2352x1568px: 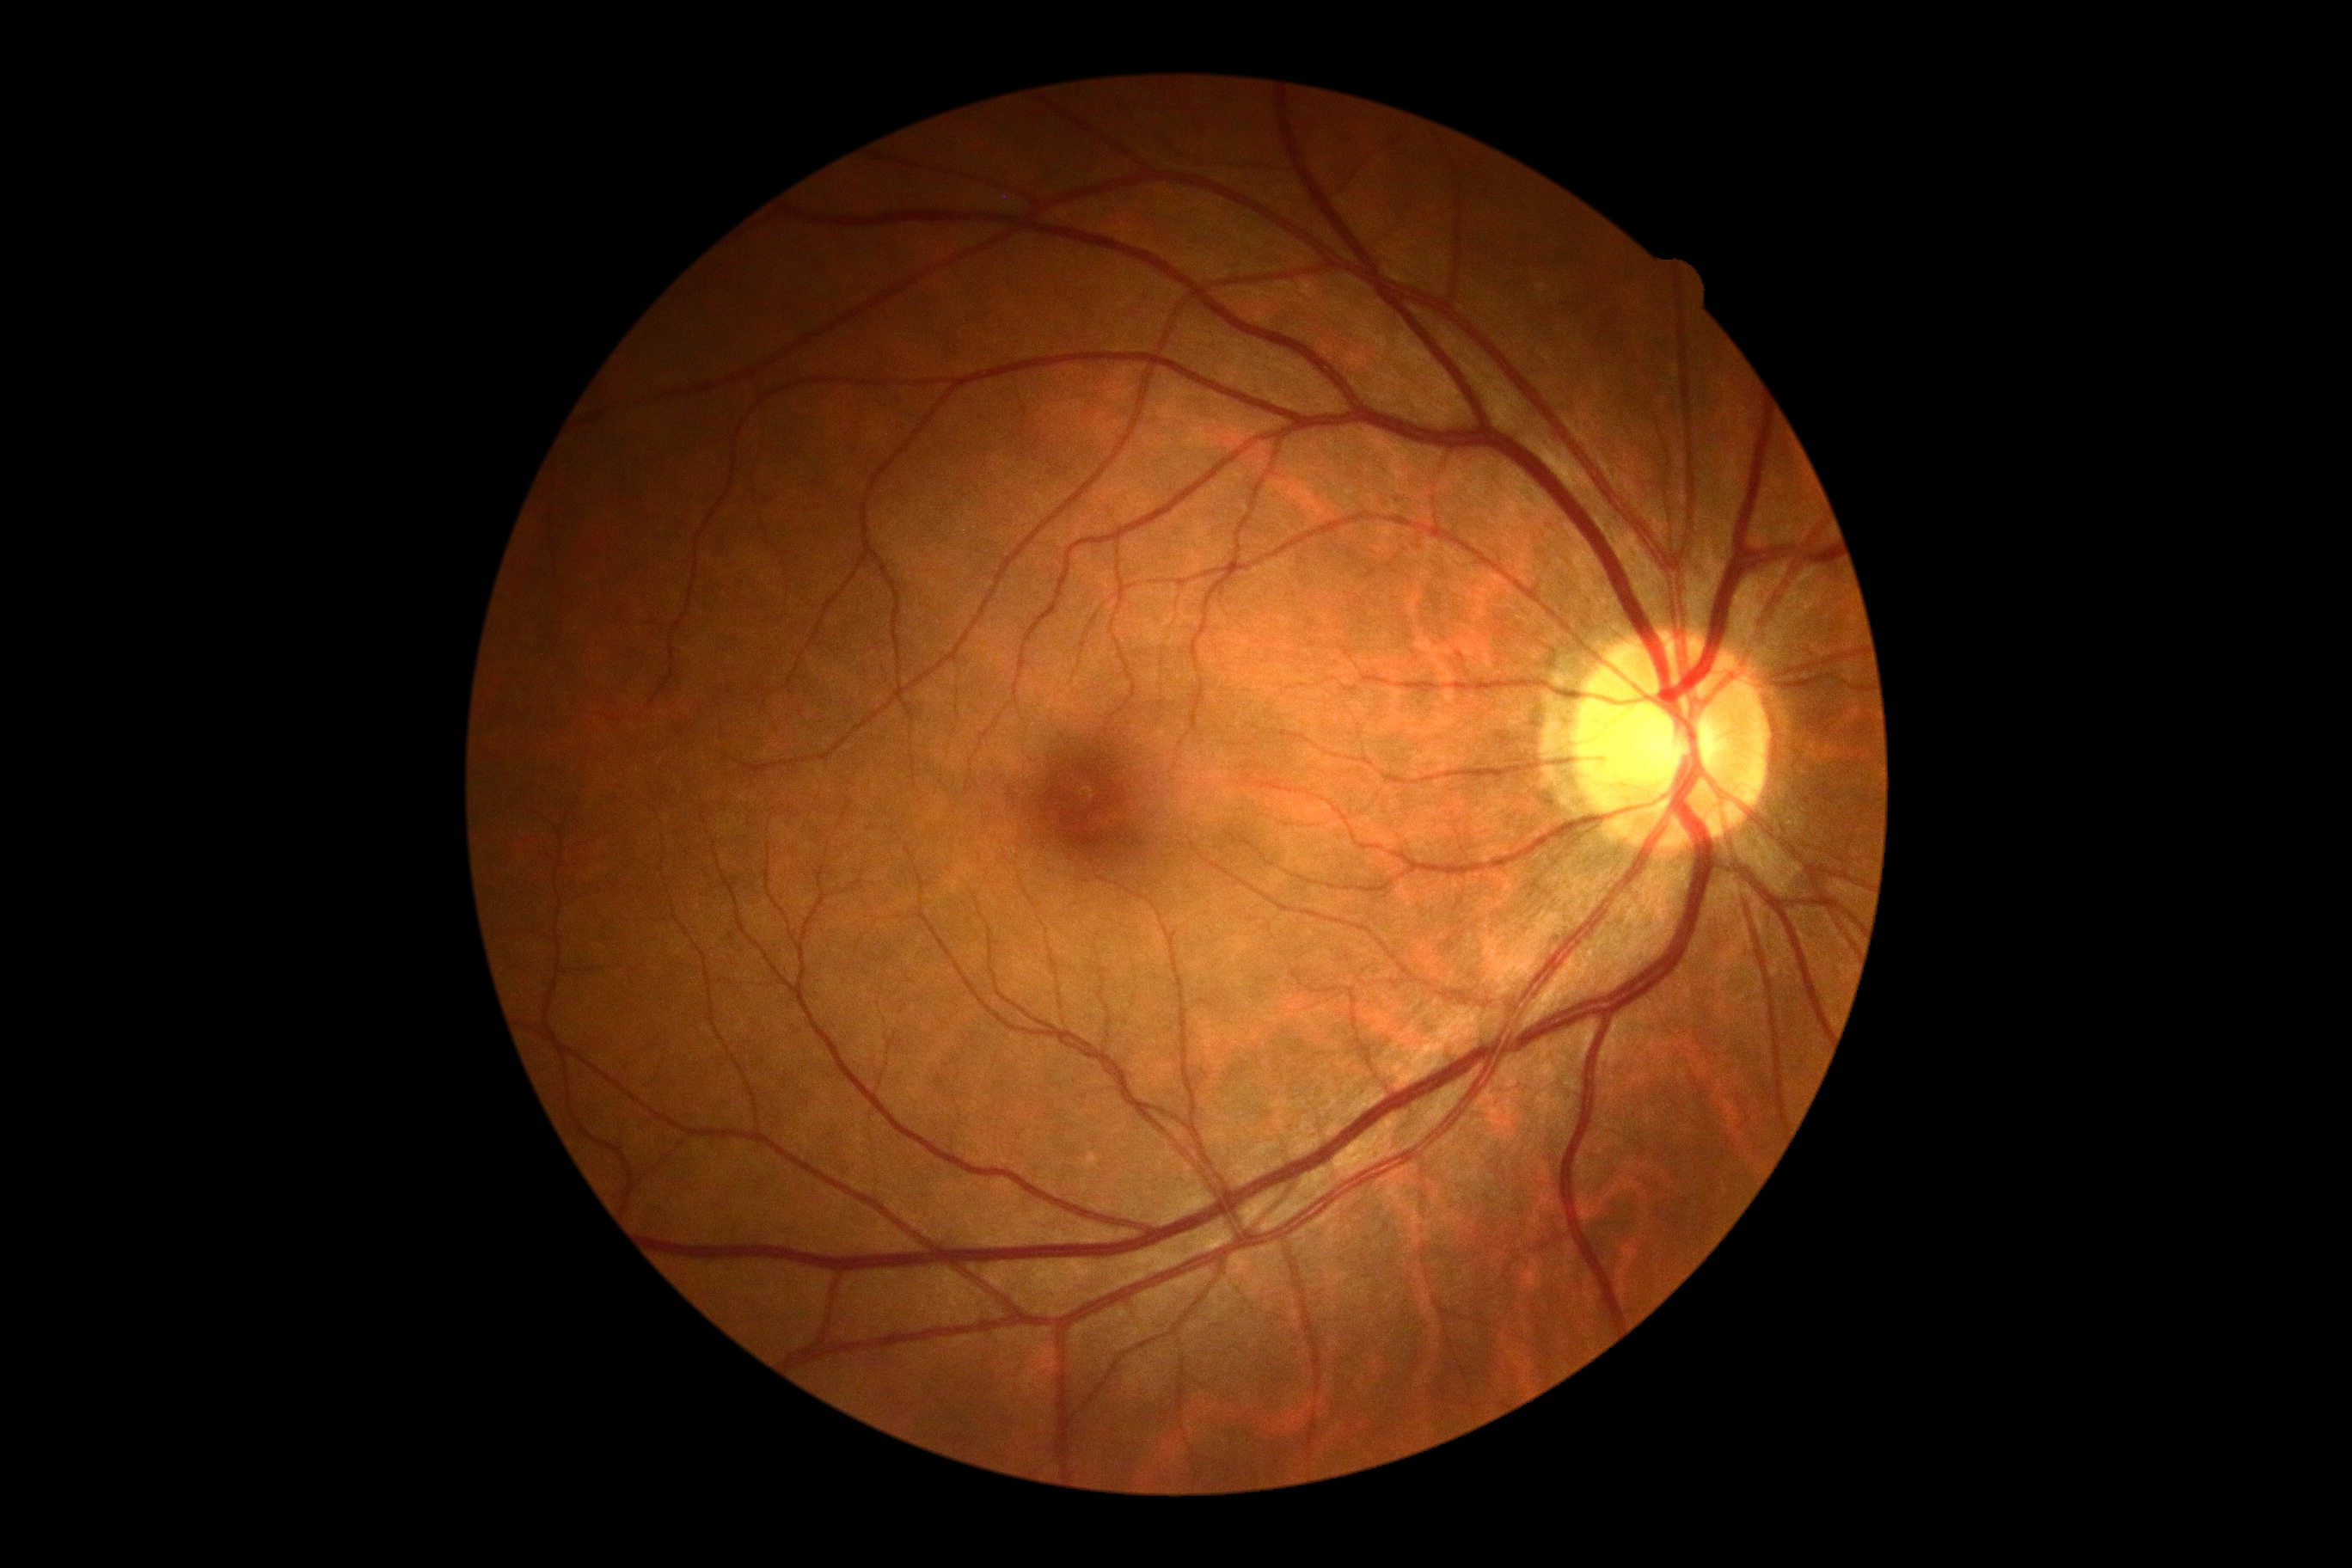

Diabetic retinopathy (DR) is 0.